Color fundus photograph:
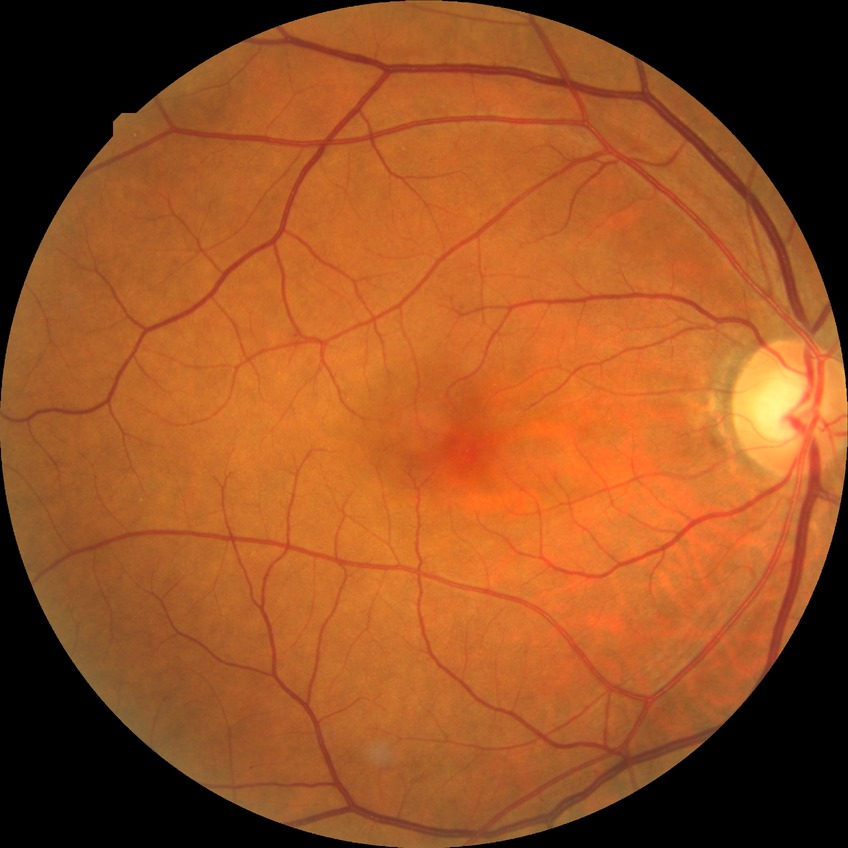
Diabetic retinopathy (DR) is NDR (no diabetic retinopathy).